Disc-centered field, retinal fundus photograph — 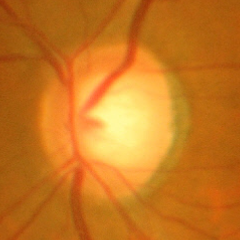

Findings consistent with no glaucomatous findings.